Infant wide-field retinal image
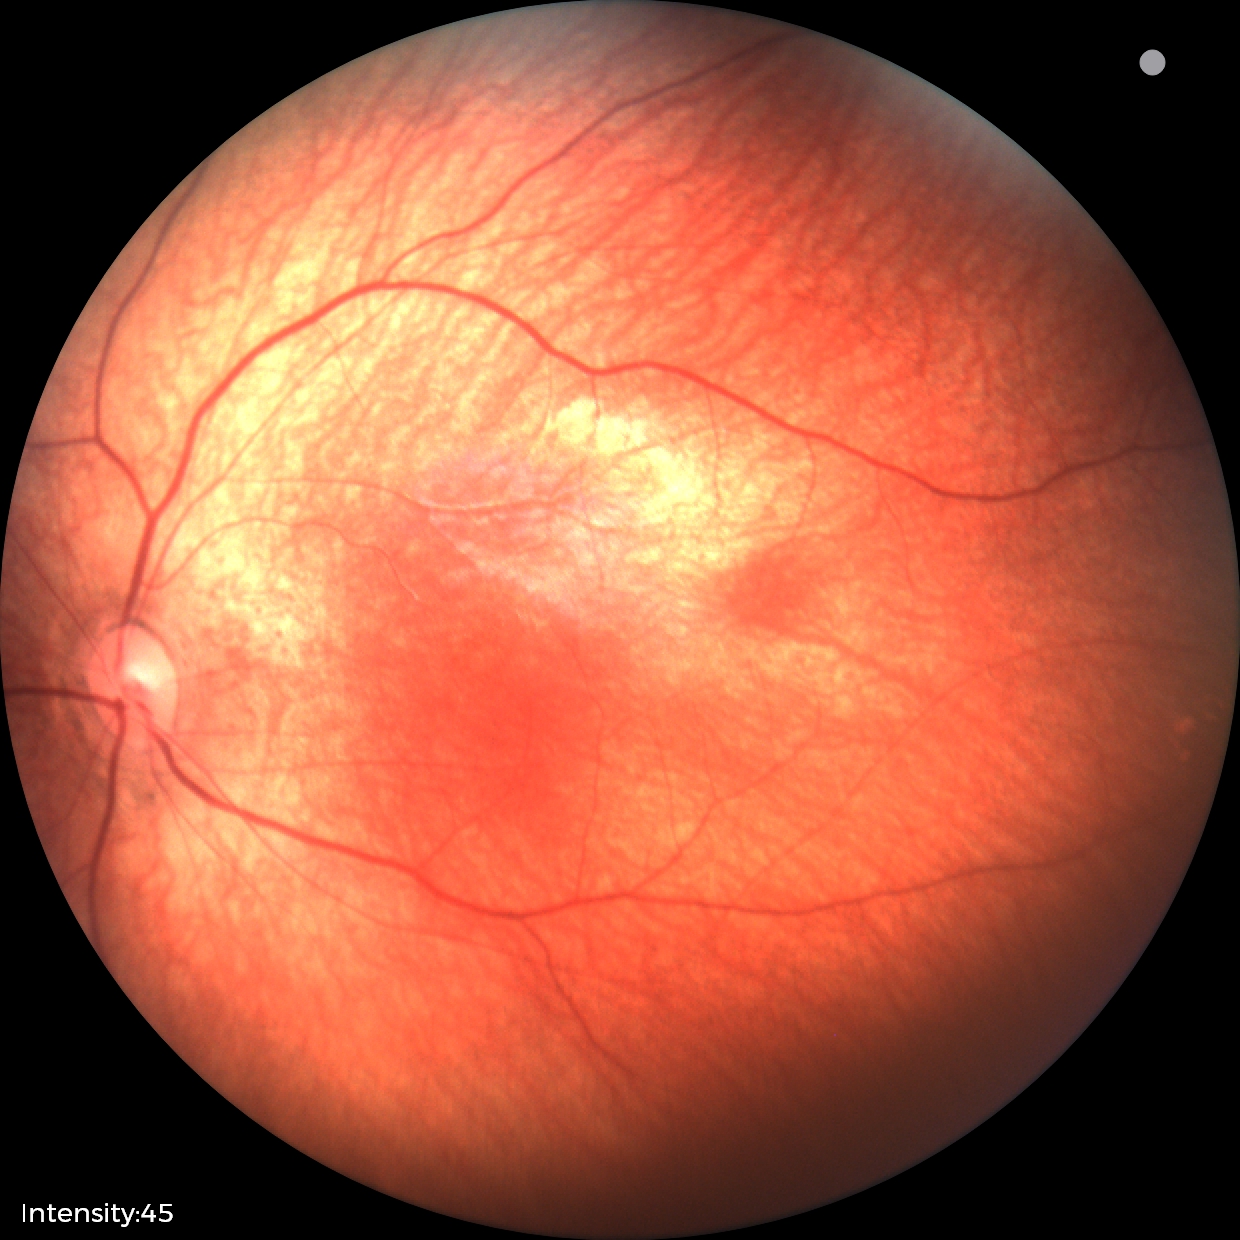

Impression: no abnormal retinal findings.